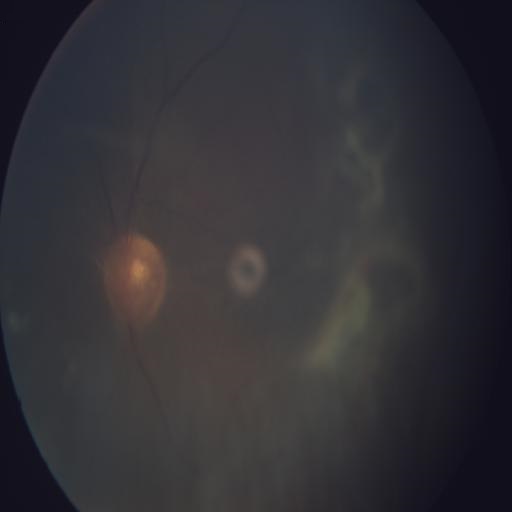
Findings: RT (retinal traction).